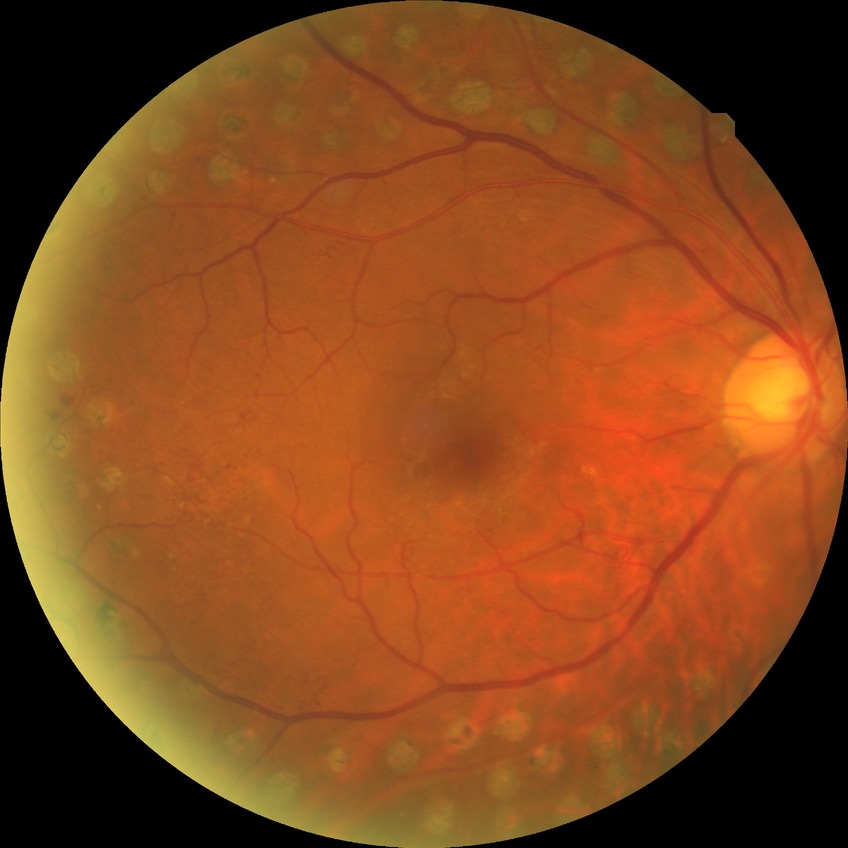 {
  "davis_grade": "proliferative diabetic retinopathy"
}